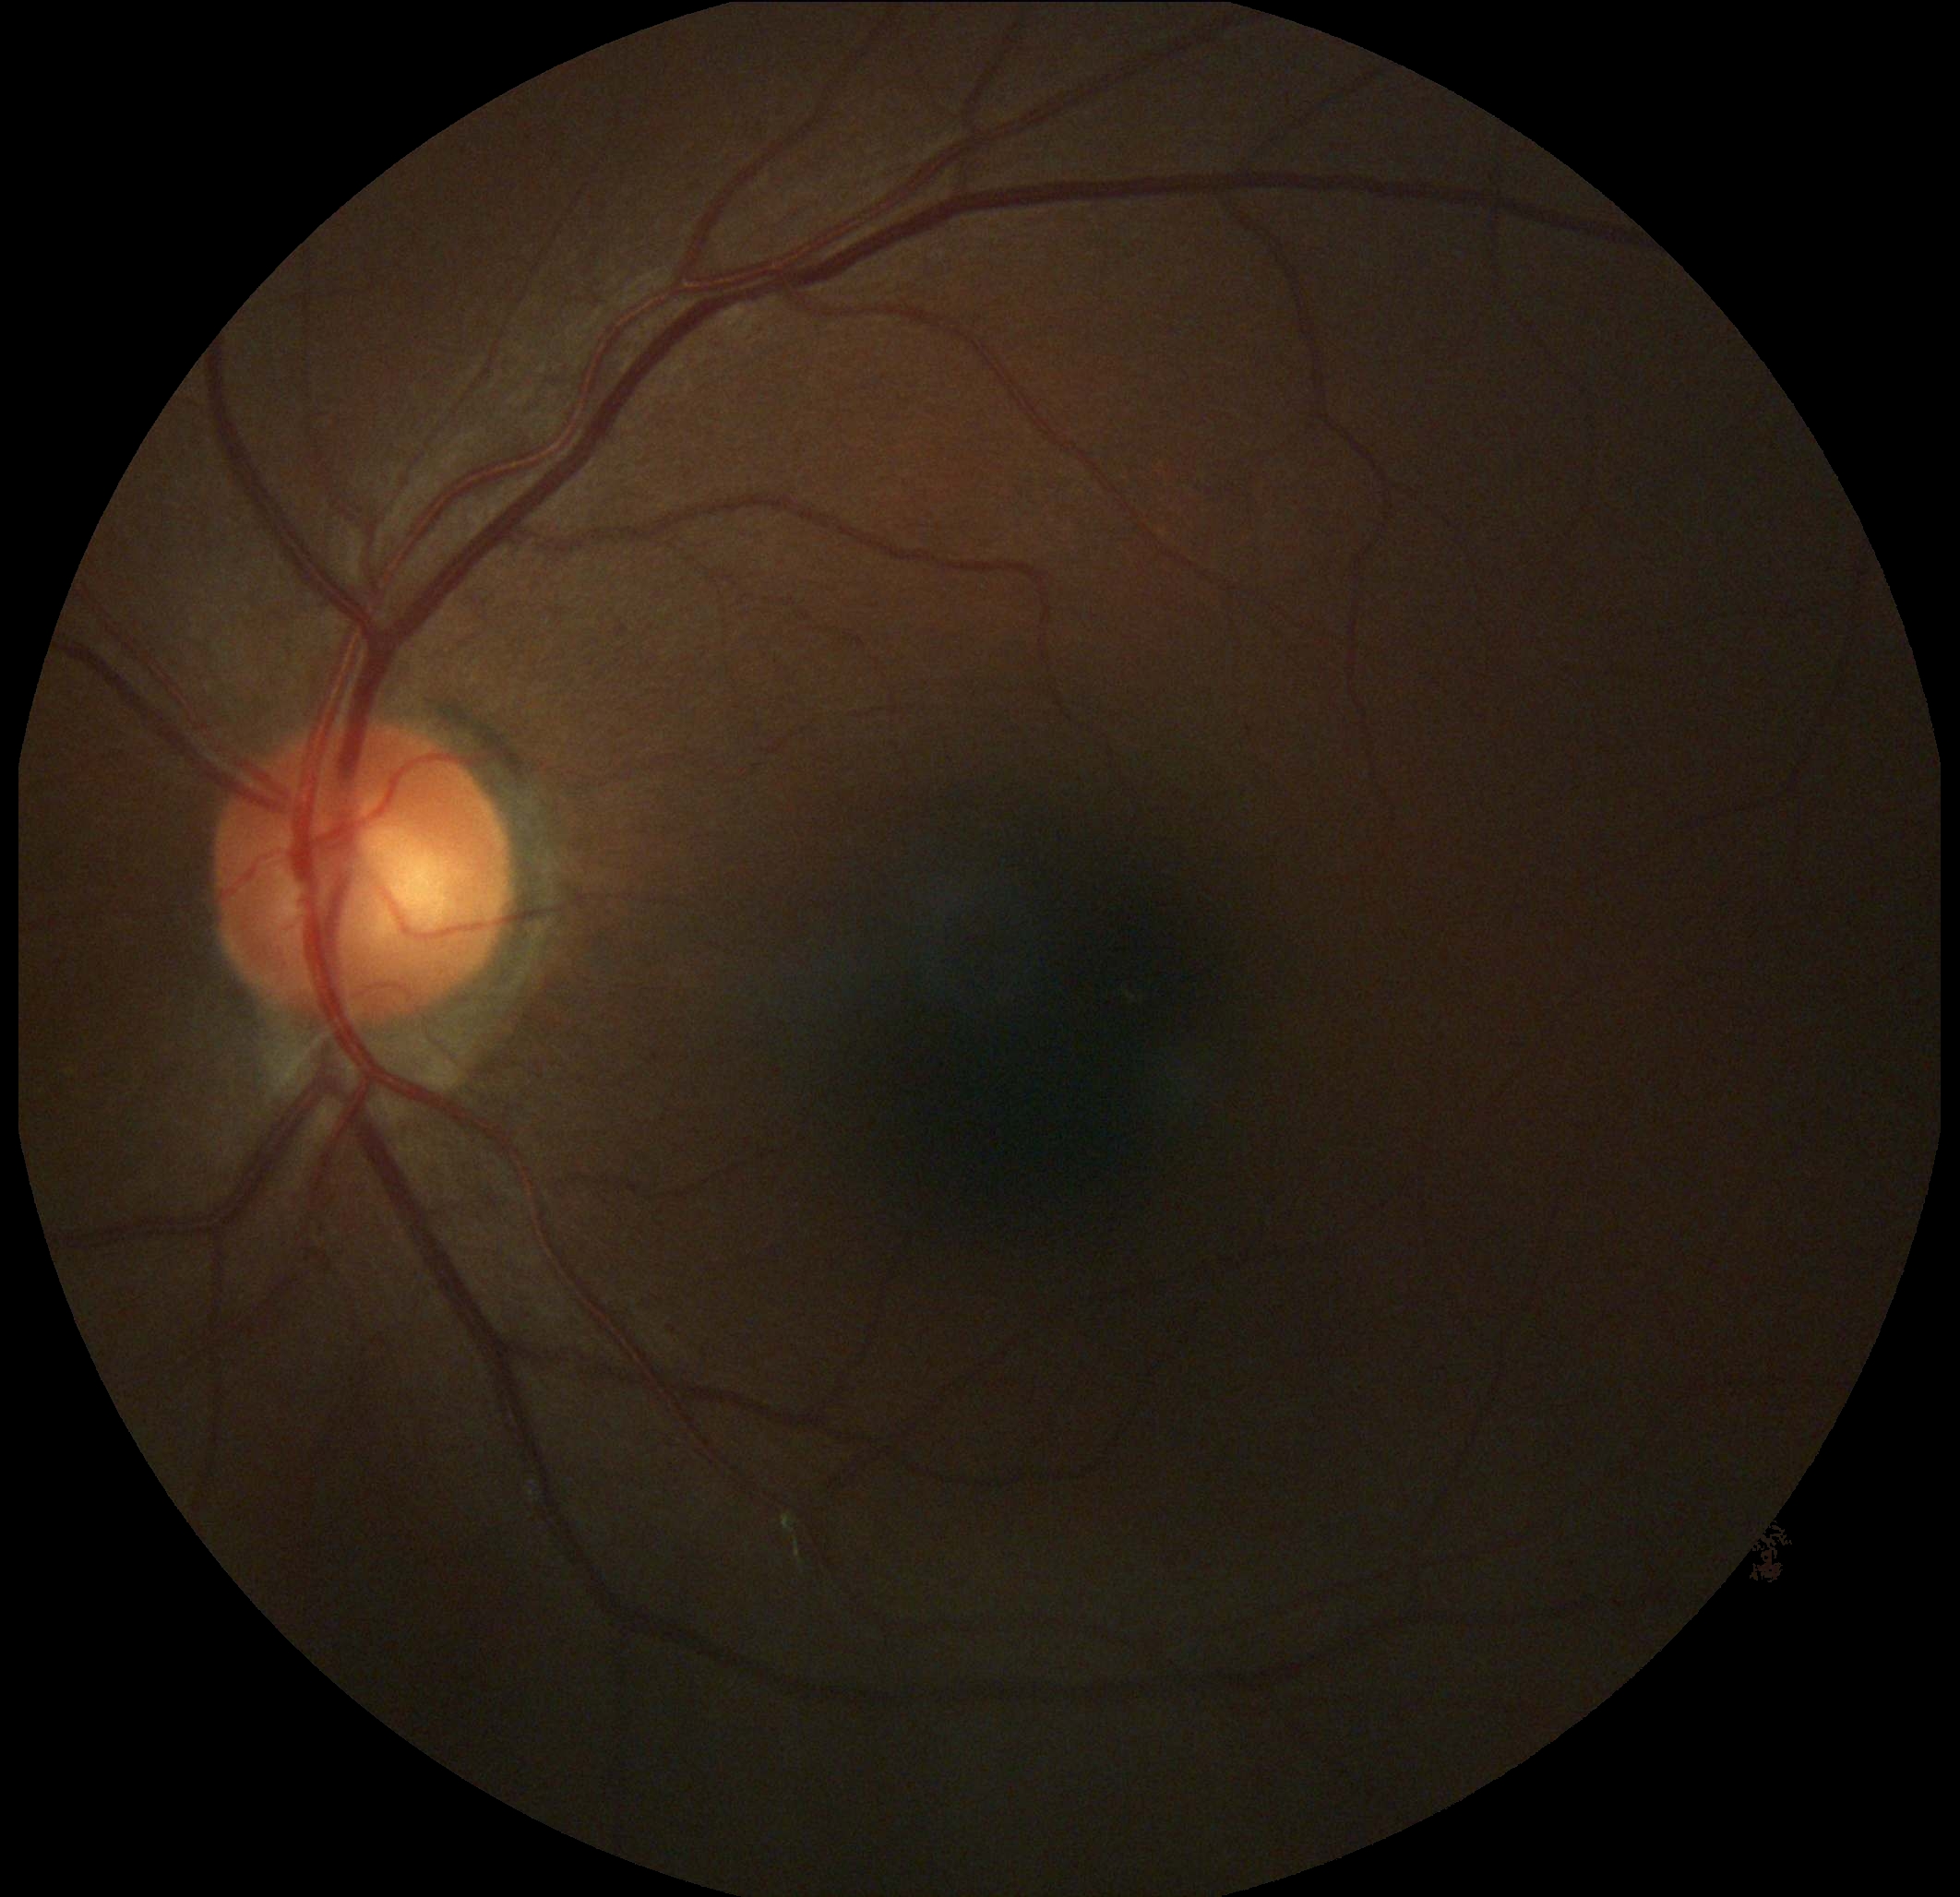
Diabetic retinopathy is grade 0 (no apparent retinopathy).
No apparent diabetic retinopathy.